Retinal fundus photograph:
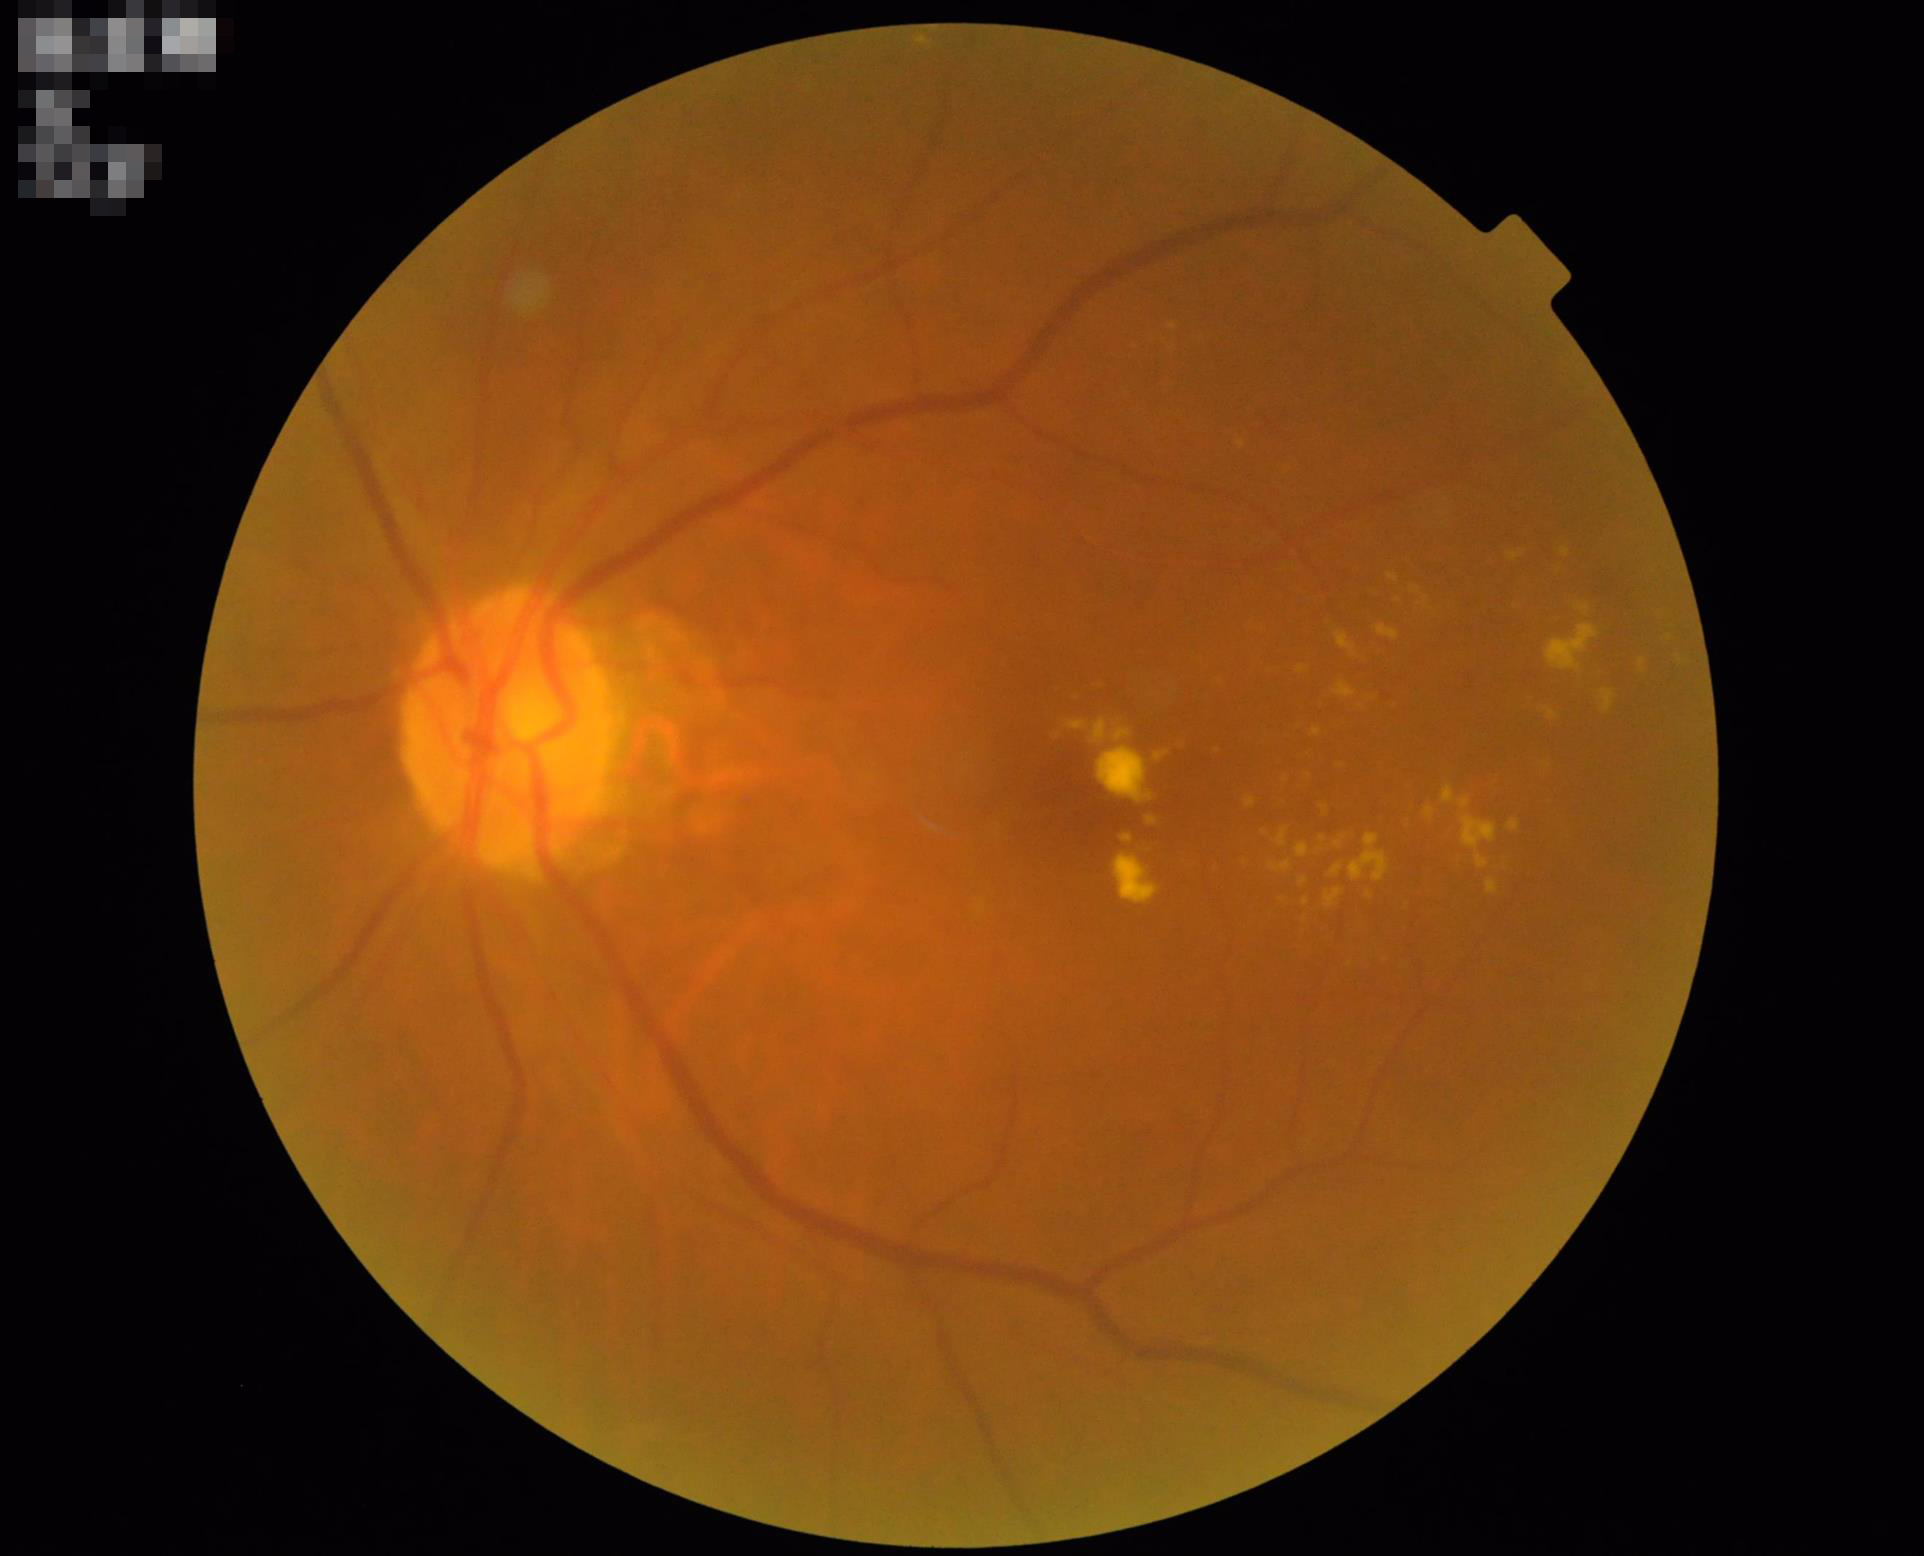
Optic disc, vessels, and background are in focus. Acceptable image quality. No over- or under-exposure. Good dynamic range.